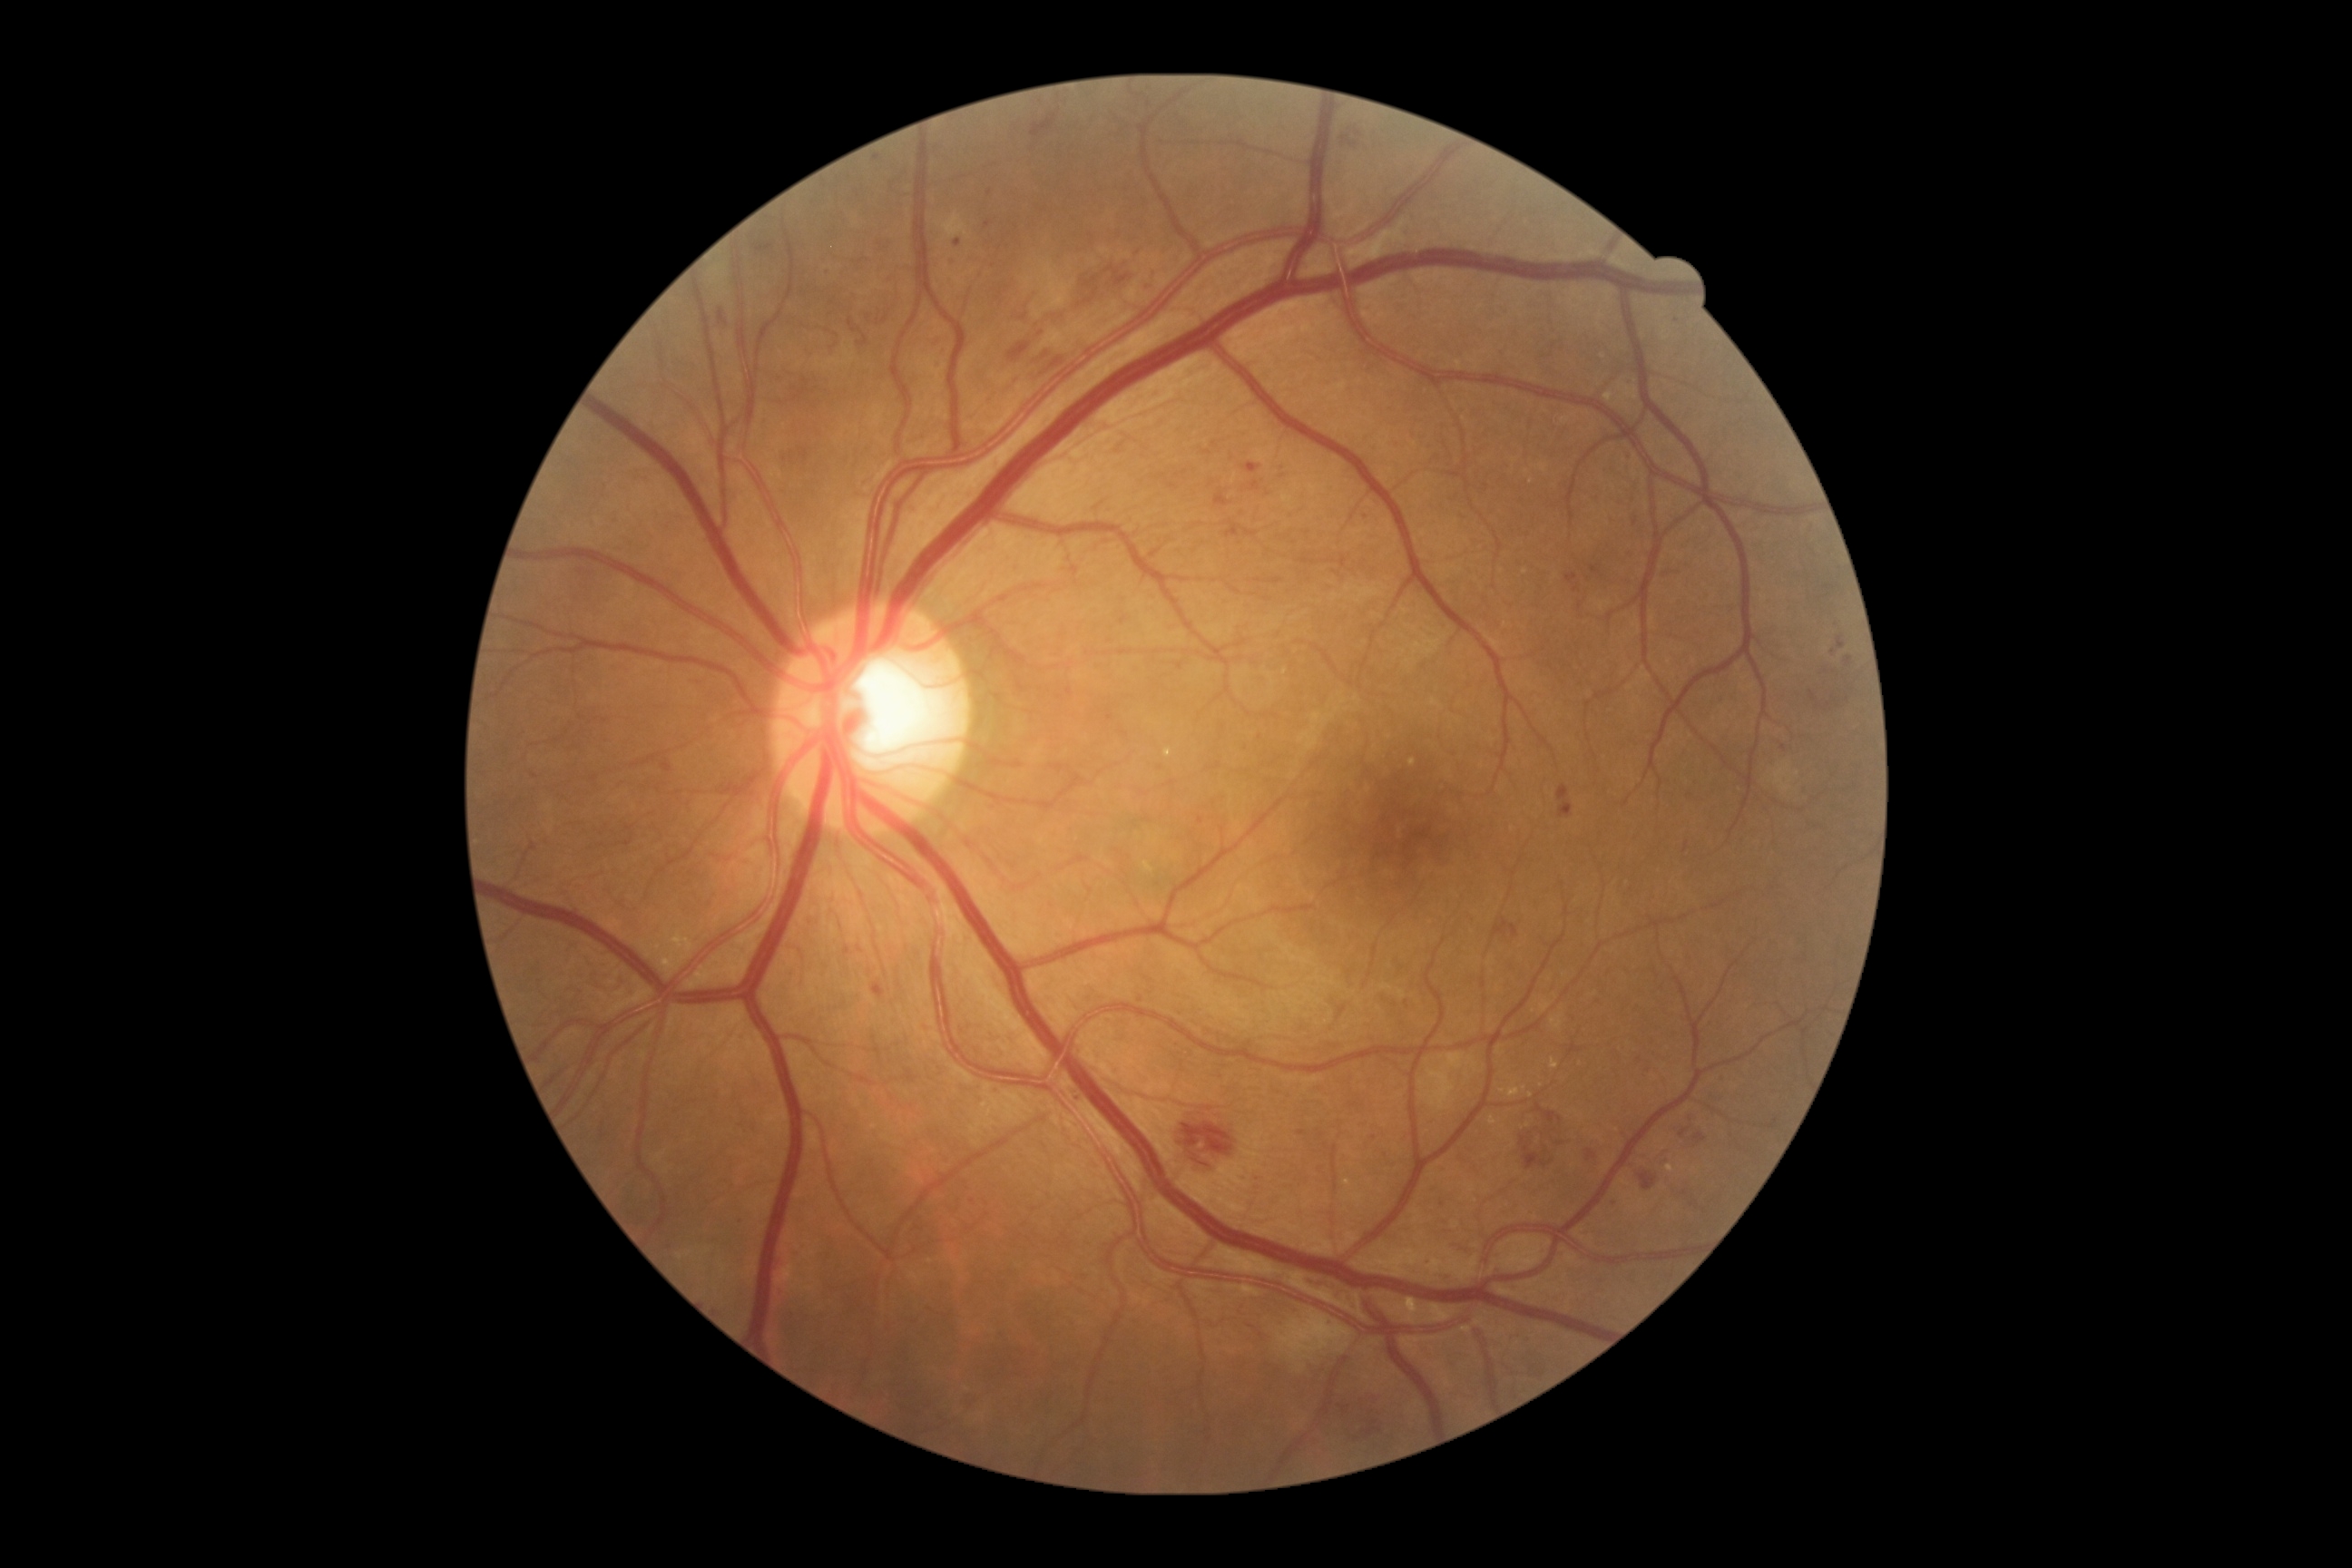 Retinopathy grade: 3
Representative lesions:
* soft exudates: none detected
* hemorrhages (continued): {"x1": 1177, "y1": 1108, "x2": 1244, "y2": 1171} | {"x1": 1344, "y1": 1393, "x2": 1386, "y2": 1440} | {"x1": 1037, "y1": 344, "x2": 1064, "y2": 375} | {"x1": 1680, "y1": 1130, "x2": 1690, "y2": 1139} | {"x1": 1558, "y1": 785, "x2": 1574, "y2": 819} | {"x1": 1453, "y1": 1244, "x2": 1475, "y2": 1255} | {"x1": 1683, "y1": 843, "x2": 1689, "y2": 852} | {"x1": 1694, "y1": 1133, "x2": 1707, "y2": 1146} | {"x1": 1493, "y1": 917, "x2": 1518, "y2": 939} | {"x1": 1006, "y1": 311, "x2": 1064, "y2": 364}
* Additional small hemorrhages near Point(1837, 703) | Point(1819, 707)
* hard exudates (continued): {"x1": 1551, "y1": 1059, "x2": 1560, "y2": 1070} | {"x1": 1509, "y1": 1083, "x2": 1522, "y2": 1099} | {"x1": 1144, "y1": 861, "x2": 1155, "y2": 874} | {"x1": 1605, "y1": 393, "x2": 1614, "y2": 402} | {"x1": 1164, "y1": 749, "x2": 1173, "y2": 760}
* Additional small hard exudates near Point(1526, 571) | Point(1525, 1089) | Point(669, 954) | Point(1529, 1126) | Point(1502, 1091) | Point(665, 966) | Point(1542, 1086) | Point(1492, 1120) | Point(1412, 763) | Point(1531, 1096) | Point(1670, 1168)
* microaneurysms (continued): {"x1": 1215, "y1": 493, "x2": 1231, "y2": 507} | {"x1": 1587, "y1": 1150, "x2": 1596, "y2": 1161} | {"x1": 845, "y1": 946, "x2": 850, "y2": 956} | {"x1": 1224, "y1": 522, "x2": 1242, "y2": 538} | {"x1": 1836, "y1": 634, "x2": 1847, "y2": 651} | {"x1": 1298, "y1": 1130, "x2": 1308, "y2": 1137} | {"x1": 1591, "y1": 567, "x2": 1602, "y2": 574} | {"x1": 1565, "y1": 574, "x2": 1578, "y2": 583} | {"x1": 1073, "y1": 1093, "x2": 1079, "y2": 1104}
* Additional small microaneurysms near Point(877, 159) | Point(1375, 1139) | Point(956, 263) | Point(1577, 590) | Point(1201, 821)